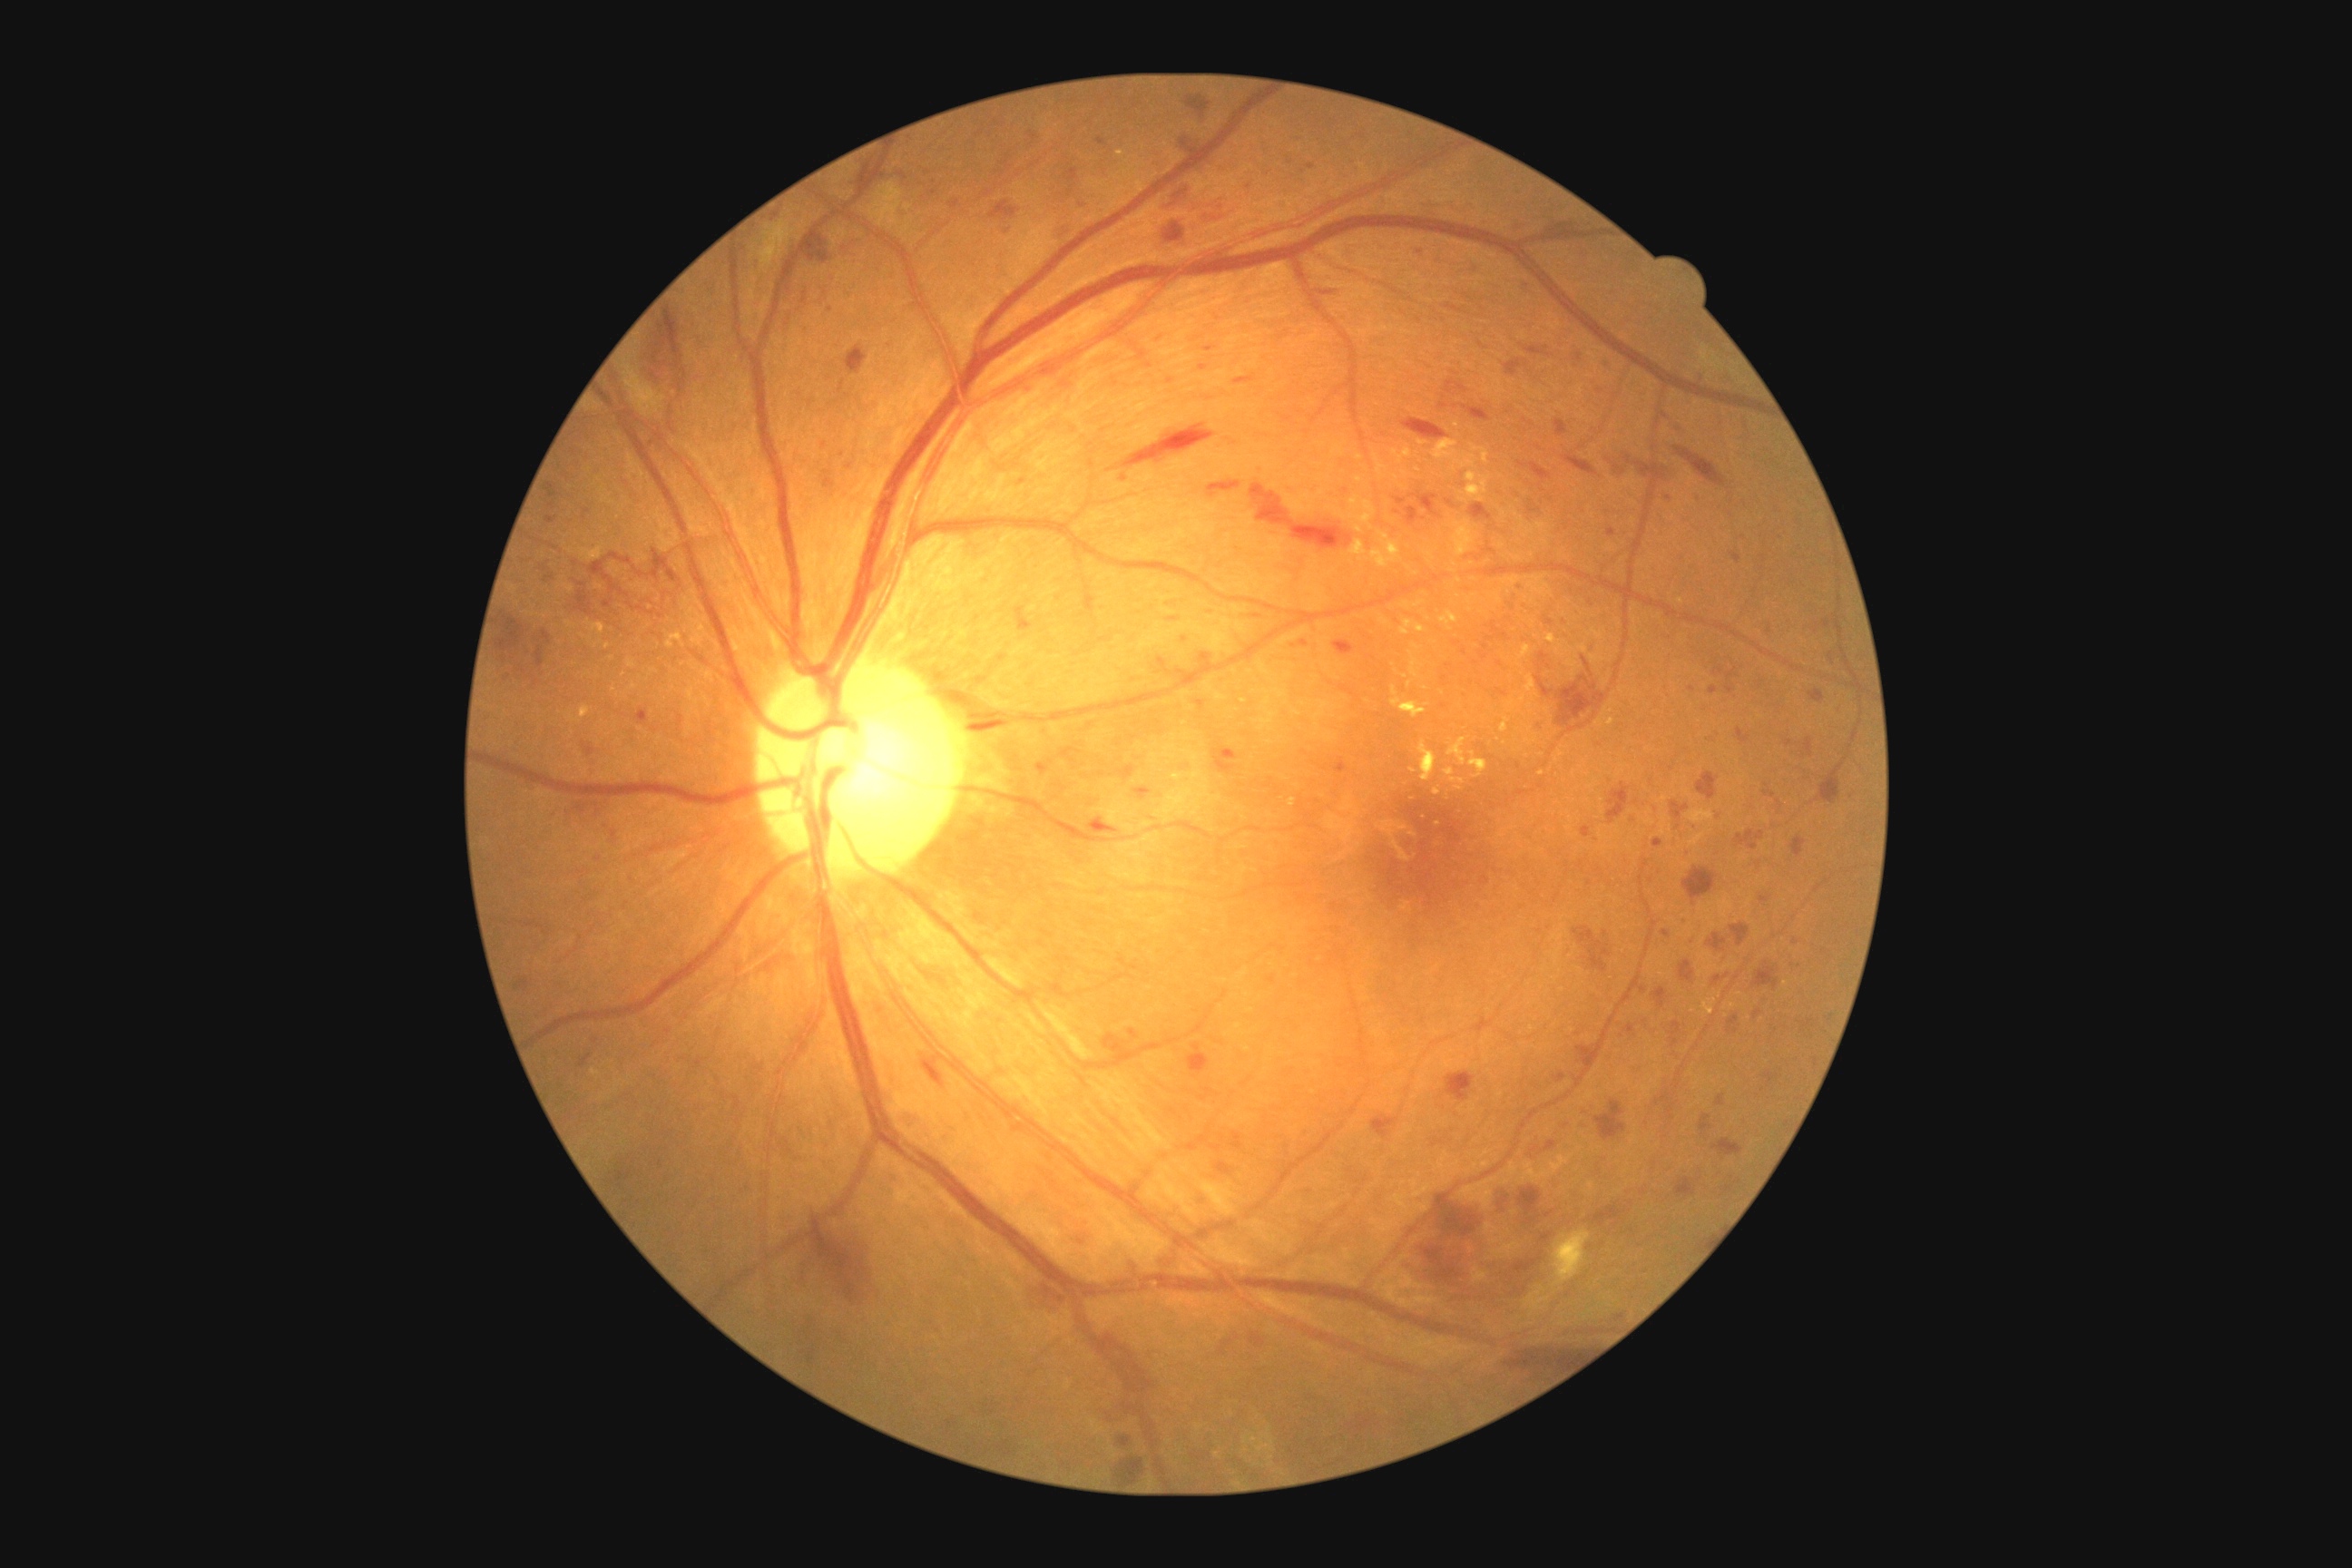 DR stage: 3
Selected lesions:
EXs (subset): 1518:645:1531:660; 1596:709:1614:727; 1173:772:1182:781; 1380:549:1402:565; 1117:150:1126:157; 1349:495:1362:511; 1451:778:1465:785; 1369:549:1380:560; 605:643:611:651; 1391:687:1427:718; 1447:738:1467:765
Smaller EXs around <point>1425, 689</point>; <point>611, 659</point>; <point>1410, 684</point>; <point>1459, 788</point>; <point>1342, 516</point>; <point>1245, 701</point>; <point>1436, 792</point>; <point>1680, 600</point>
SEs: 1553:1231:1591:1286
MAs (subset): 1694:495:1703:502; 1625:1024:1636:1037; 1199:652:1211:662; 1097:137:1106:146; 1582:827:1591:838; 1709:687:1720:694; 1765:830:1769:839; 1300:640:1308:647
Smaller MAs around <point>1580, 864</point>; <point>1007, 232</point>; <point>1692, 689</point>; <point>1520, 587</point>; <point>599, 859</point>; <point>1397, 512</point>; <point>1308, 1133</point>; <point>1669, 499</point>; <point>1826, 625</point>
HEs (subset): 1168:618:1179:623; 1406:507:1420:525; 1396:498:1407:505; 1402:418:1447:440; 1206:346:1215:351; 1188:1044:1210:1075; 1674:447:1727:487; 1206:482:1242:498; 1676:1179:1696:1199; 578:1054:593:1068; 801:291:808:306; 545:484:558:498; 1164:222:1186:244; 1792:836:1807:858; 1251:484:1353:549; 1563:455:1598:476; 540:562:551:573; 1700:1115:1714:1132; 1446:380:1469:395; 1119:1436:1132:1447